Pediatric wide-field fundus photograph · 640 x 480 pixels: 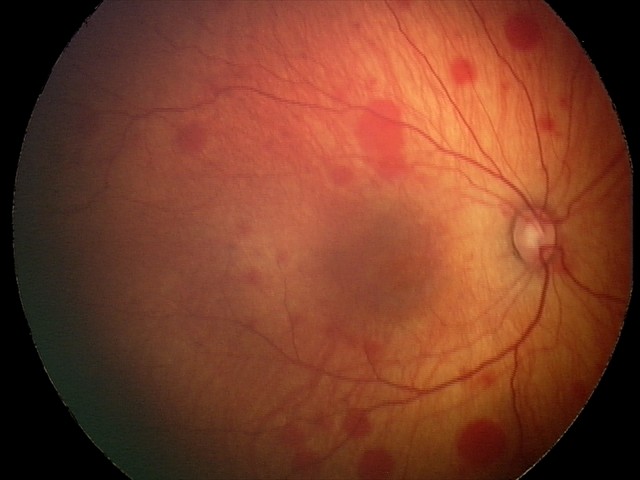 Diagnosis from this screening exam: retinal hemorrhages.